Fundus photo · 2352x1568px · 45-degree field of view: 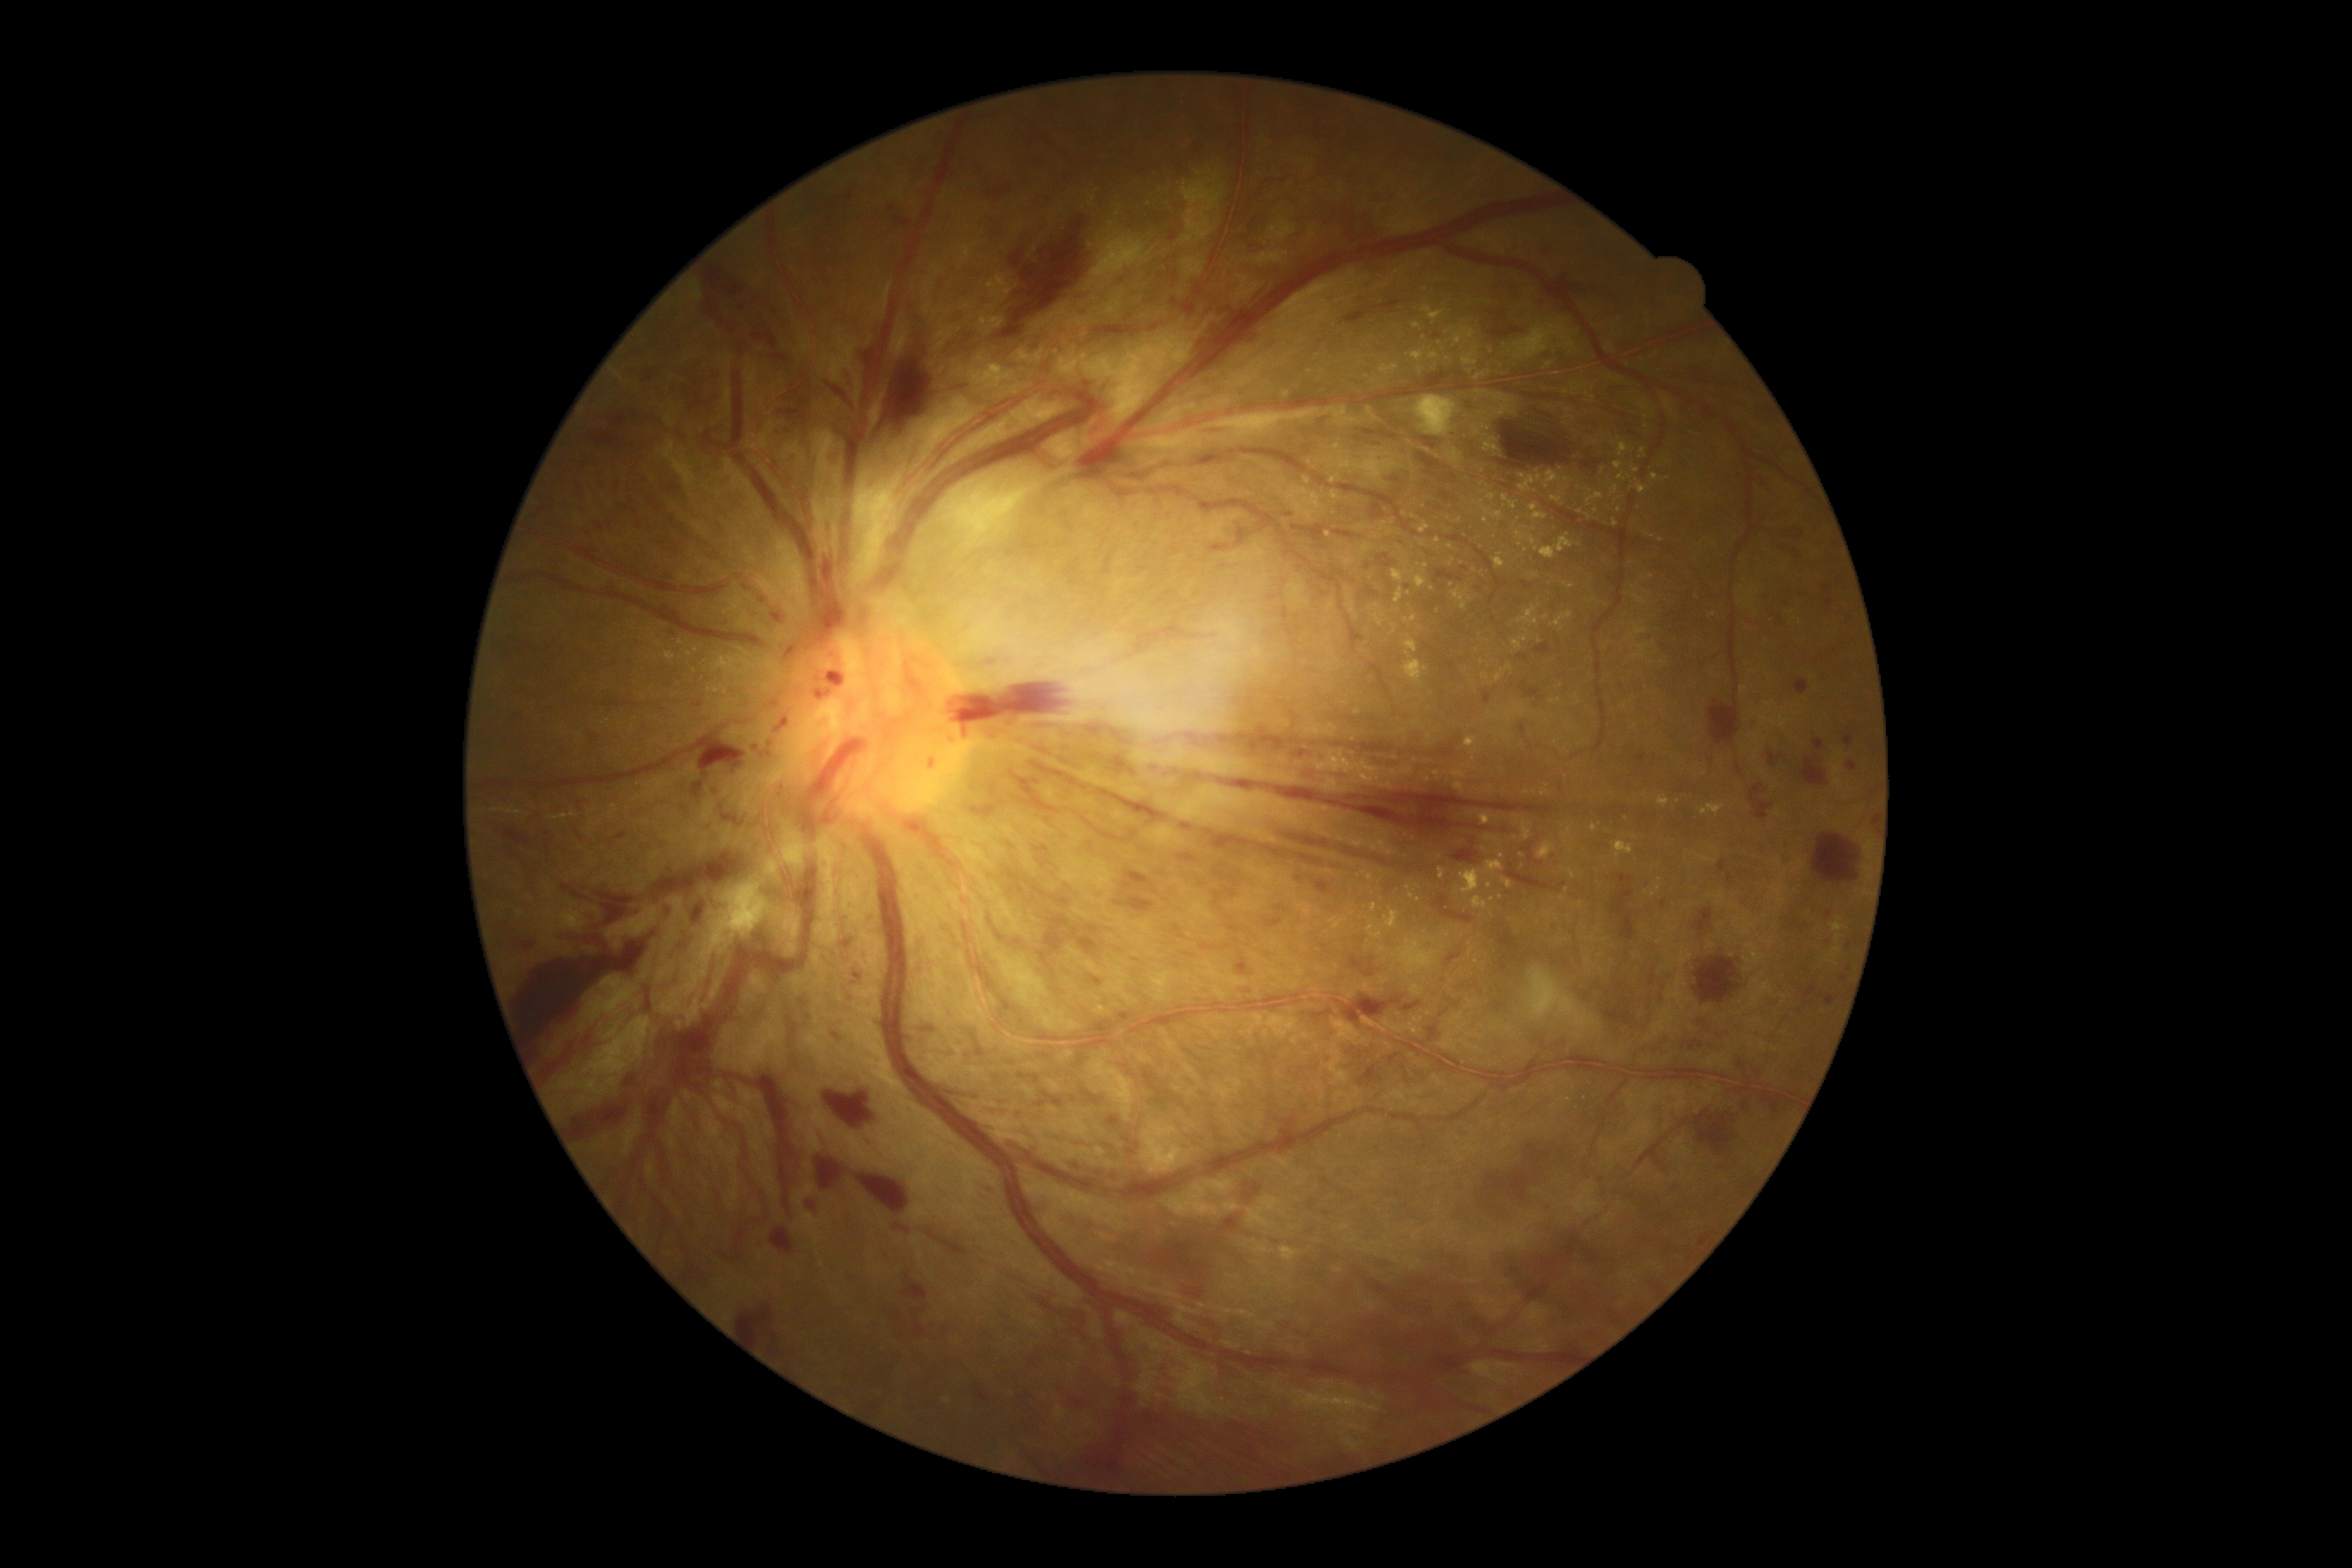 partial: true
dr_grade: 4
dr_grade_name: PDR
lesions:
  ex:
    - <box>1452,587,1474,611</box>
    - <box>1036,408,1043,419</box>
    - <box>1502,878,1514,890</box>
    - <box>1639,401,1651,412</box>
    - <box>1371,903,1378,912</box>
    - <box>1421,775,1431,783</box>
    - <box>1347,594,1357,616</box>
    - <box>1591,824,1596,833</box>
    - <box>1340,554,1356,567</box>
    - <box>1529,503,1548,520</box>
  ex_small_centers:
    - point(1421, 544)
    - point(1097, 1010)
    - point(1405, 514)
    - point(1588, 516)
    - point(1378, 537)
    - point(1651, 577)
    - point(1433, 589)
    - point(1540, 639)
    - point(1526, 630)
    - point(1311, 372)
  he:
    - <box>1117,898,1155,912</box>
    - <box>1490,326,1522,338</box>
    - <box>572,1103,627,1141</box>
    - <box>1117,1177,1256,1282</box>
    - <box>1168,297,1175,305</box>
    - <box>1038,1098,1046,1106</box>
    - <box>840,938,854,952</box>
    - <box>589,733,603,745</box>
    - <box>788,1017,799,1039</box>
    - <box>1044,917,1070,953</box>
    - <box>754,315,775,348</box>
    - <box>1089,976,1103,986</box>
    - <box>888,202,897,212</box>
    - <box>675,938,689,960</box>
    - <box>981,1185,996,1192</box>
    - <box>1197,426,1228,434</box>
    - <box>819,1149,855,1194</box>
  he_small_centers:
    - point(1436, 337)
    - point(1298, 879)